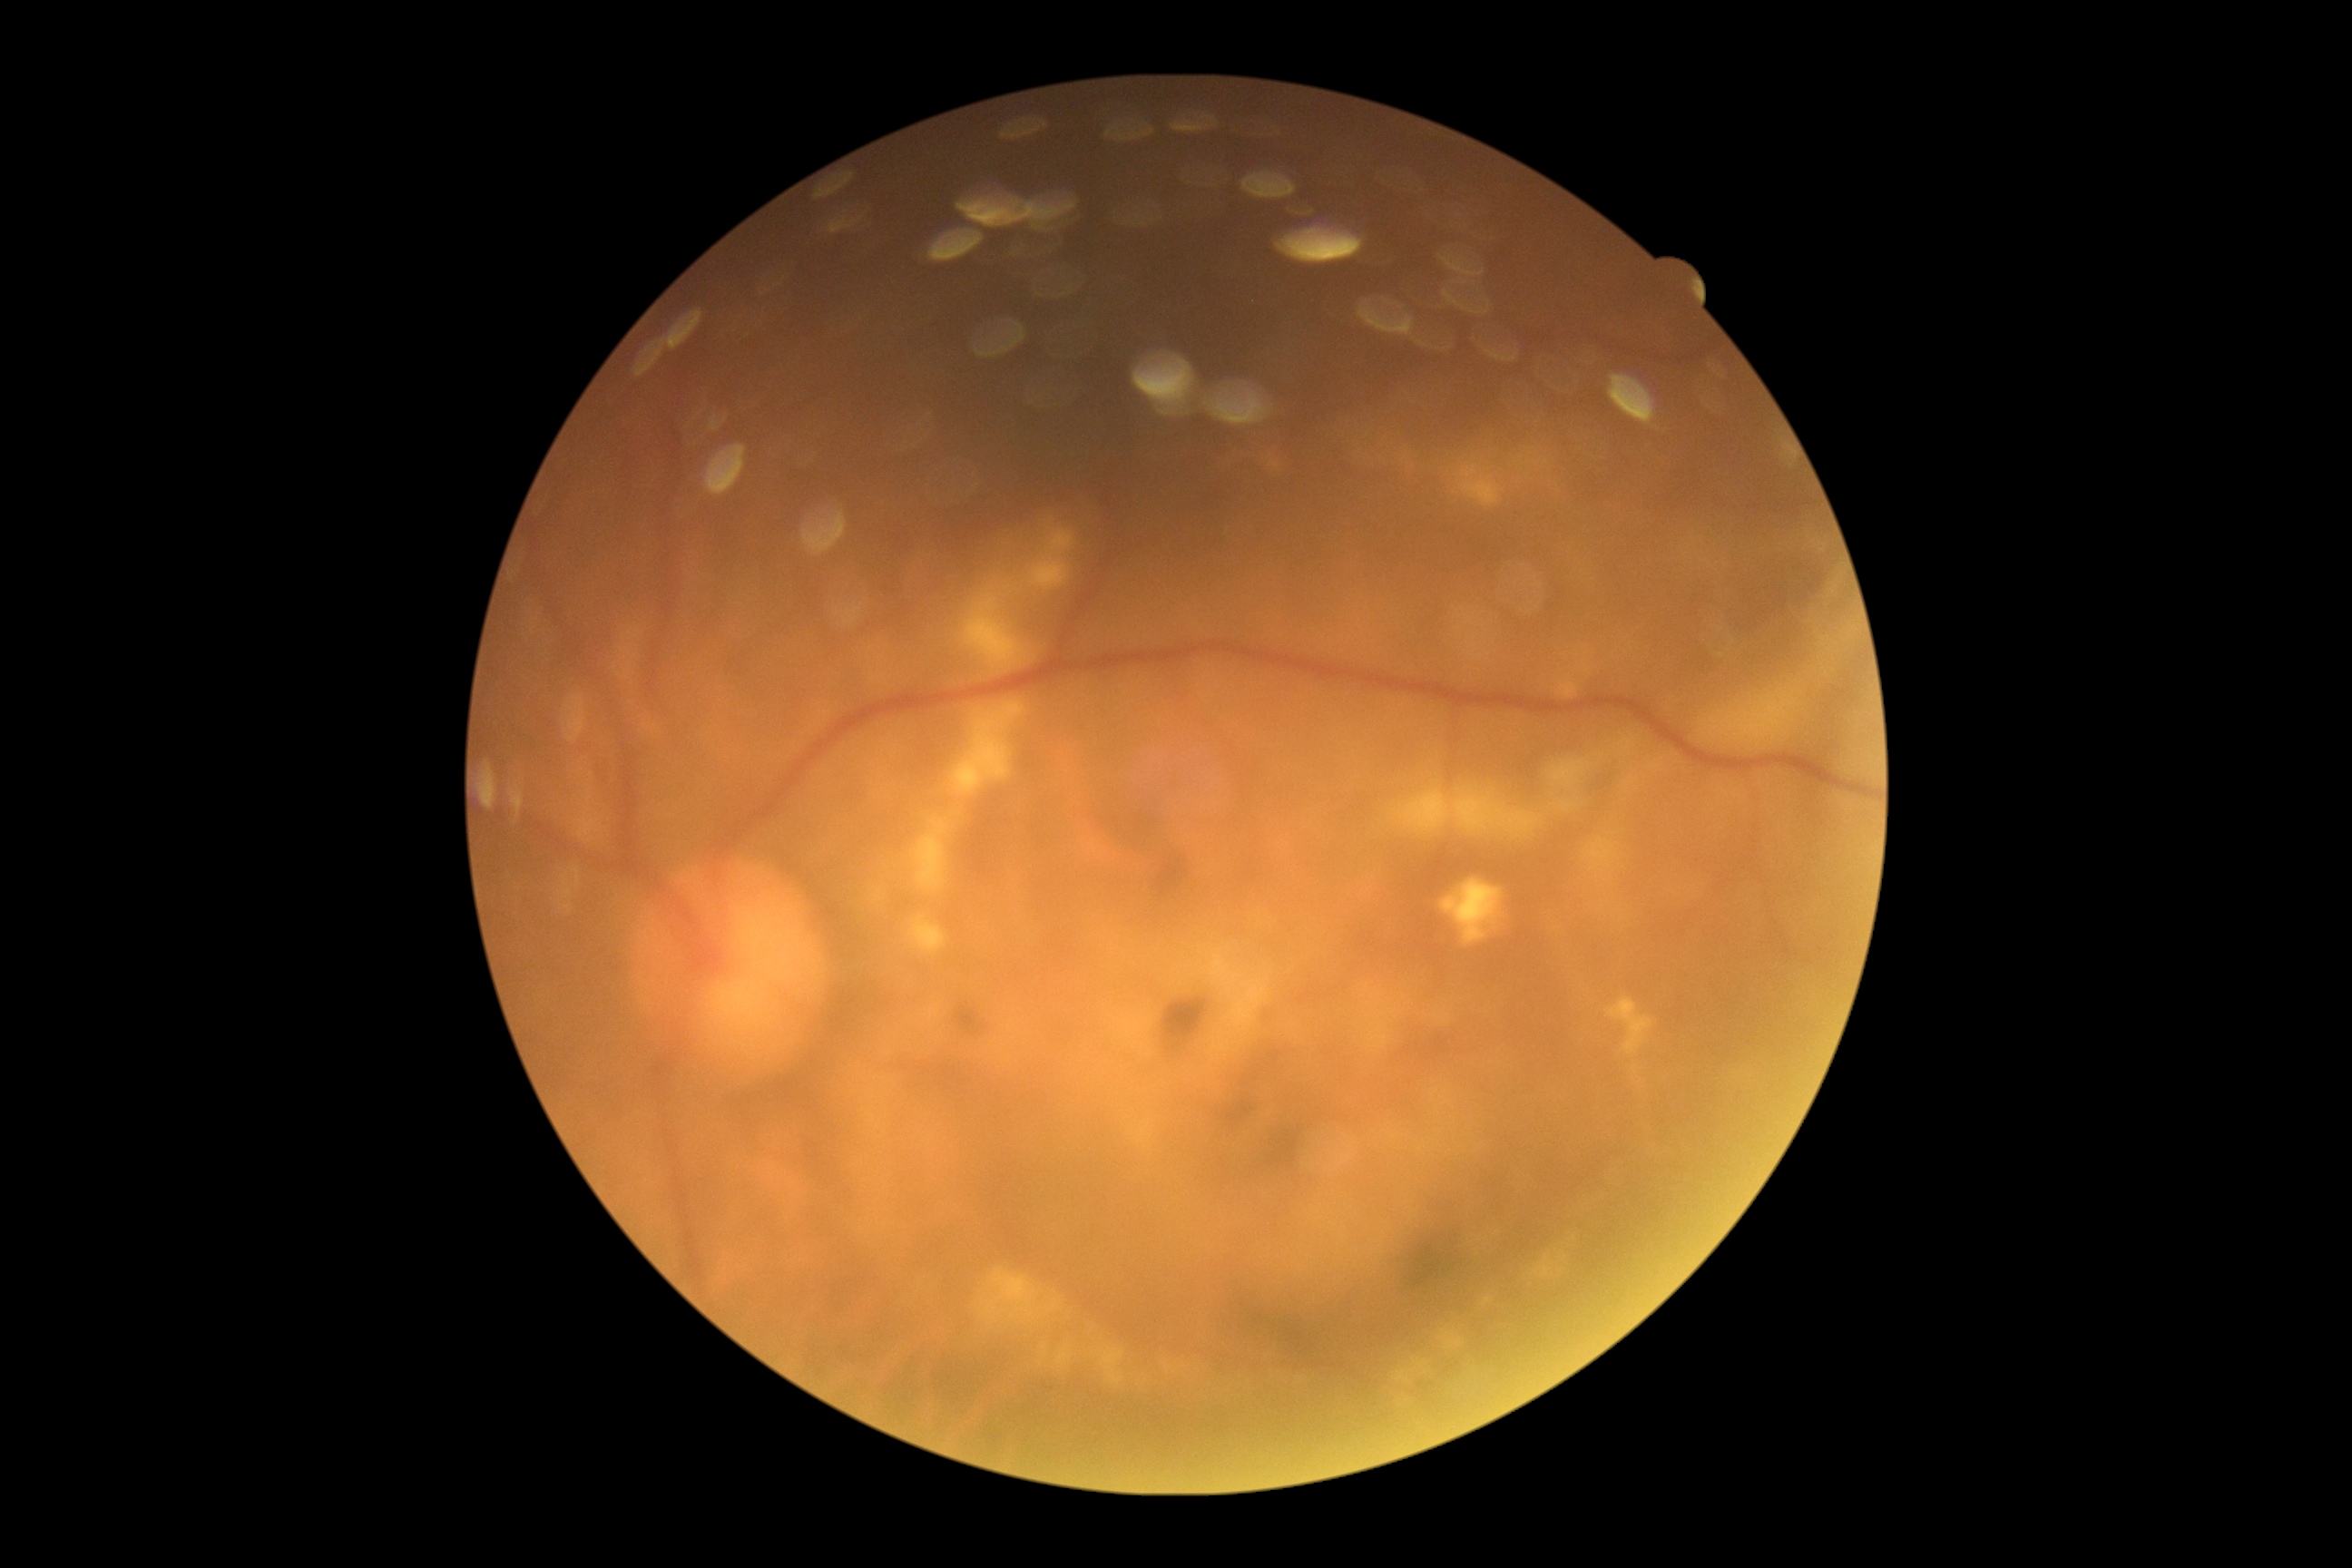
* DR grade — 2